Clarity RetCam 3, 130° FOV. Wide-field contact fundus photograph of an infant
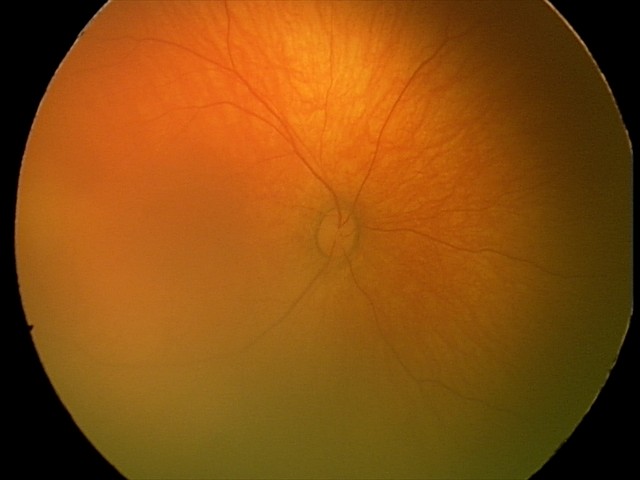 Screening examination diagnosed as physiological.